1240 x 1240 pixels; wide-field fundus image from infant ROP screening:
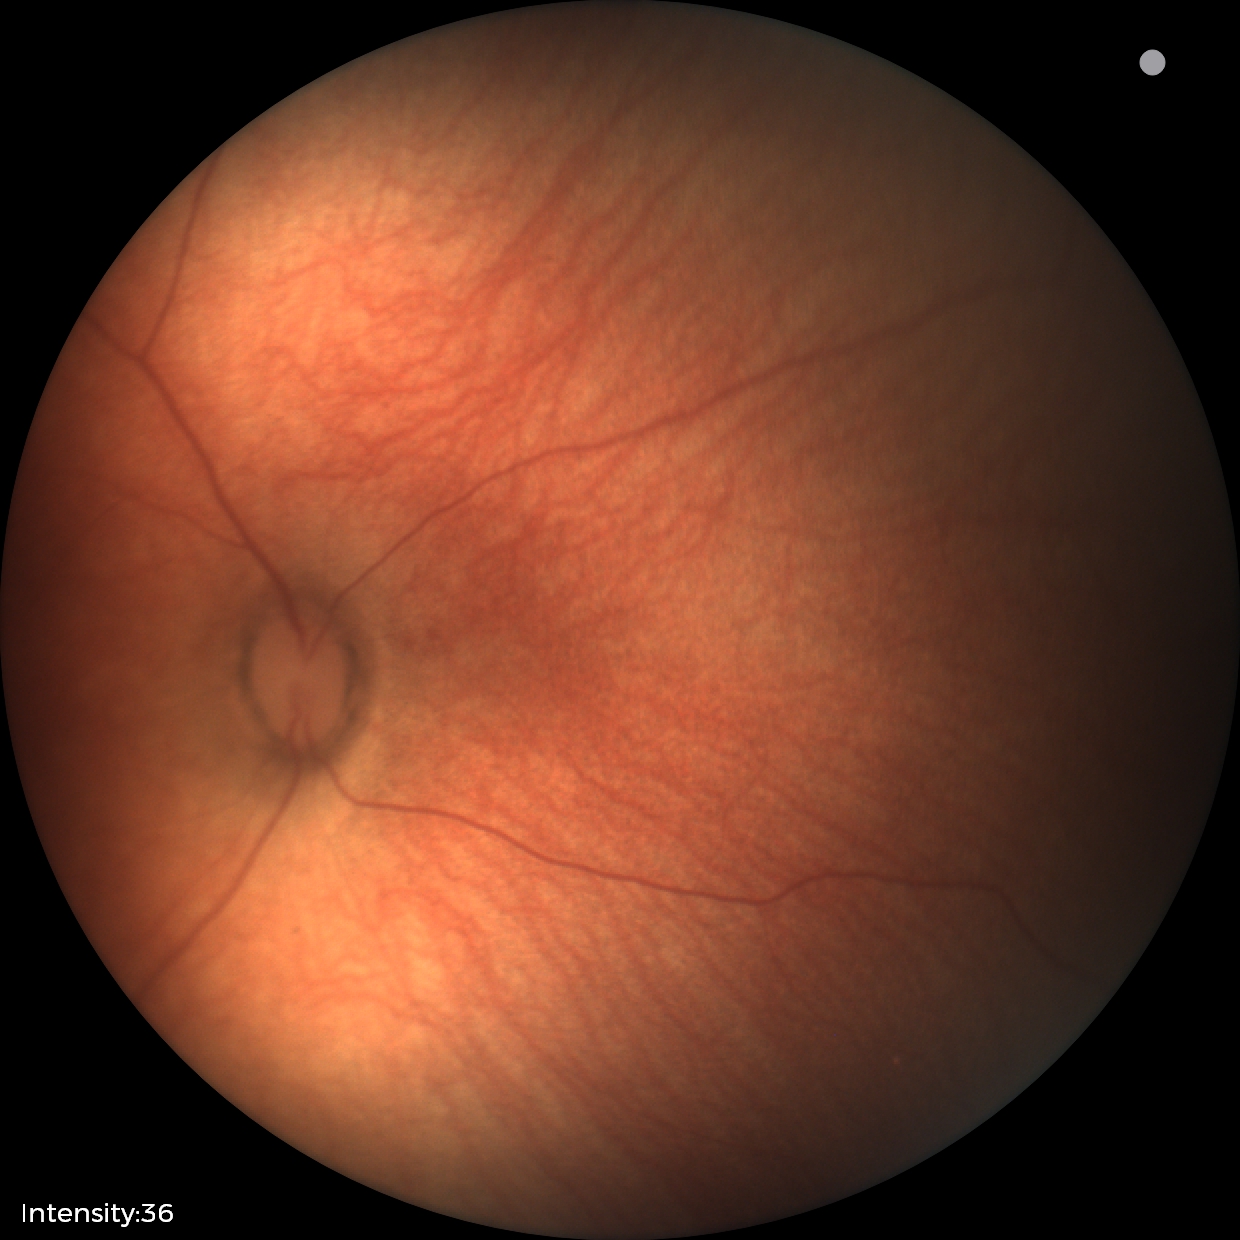 Diagnosis = physiological appearance.